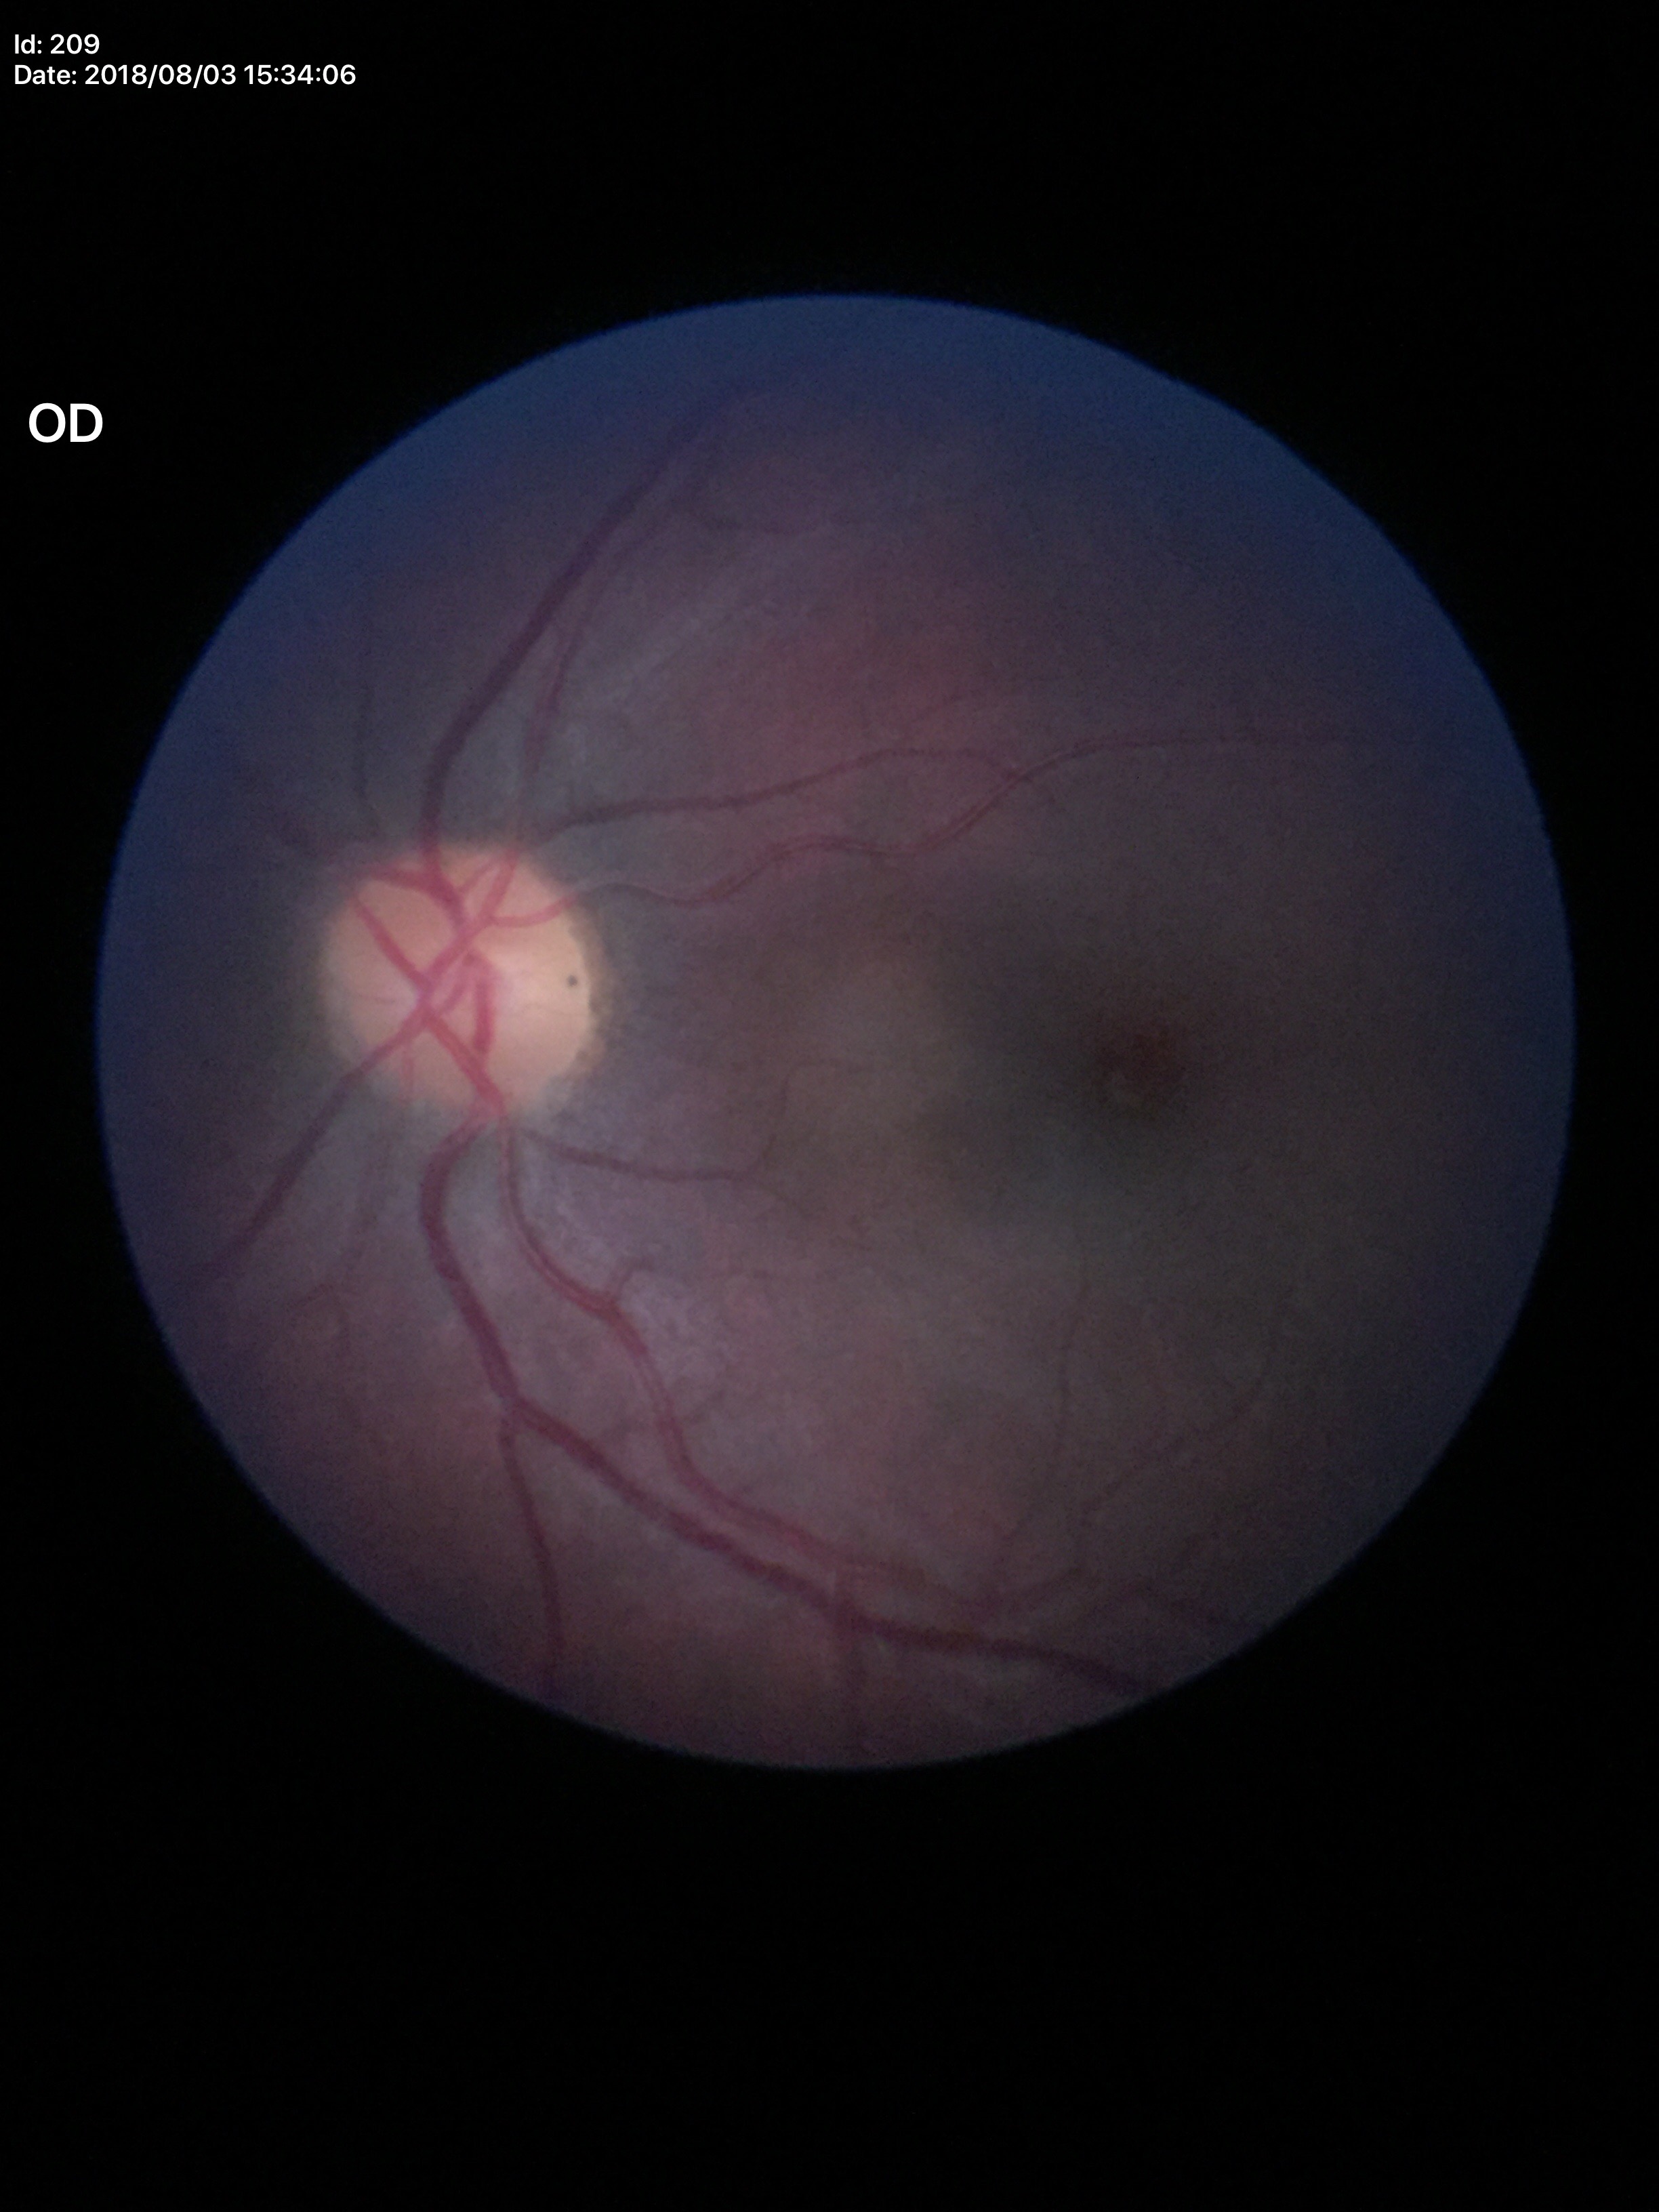

Vertical cup-disc ratio of 0.47. Horizontal cup-to-disc ratio is 0.50. No glaucomatous optic neuropathy.